Fundus photograph cropped around the optic nerve head:
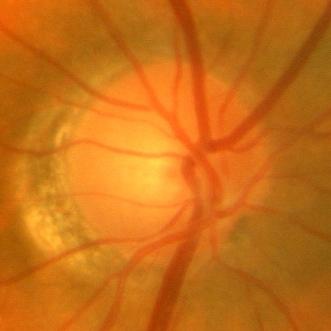

No glaucomatous damage.